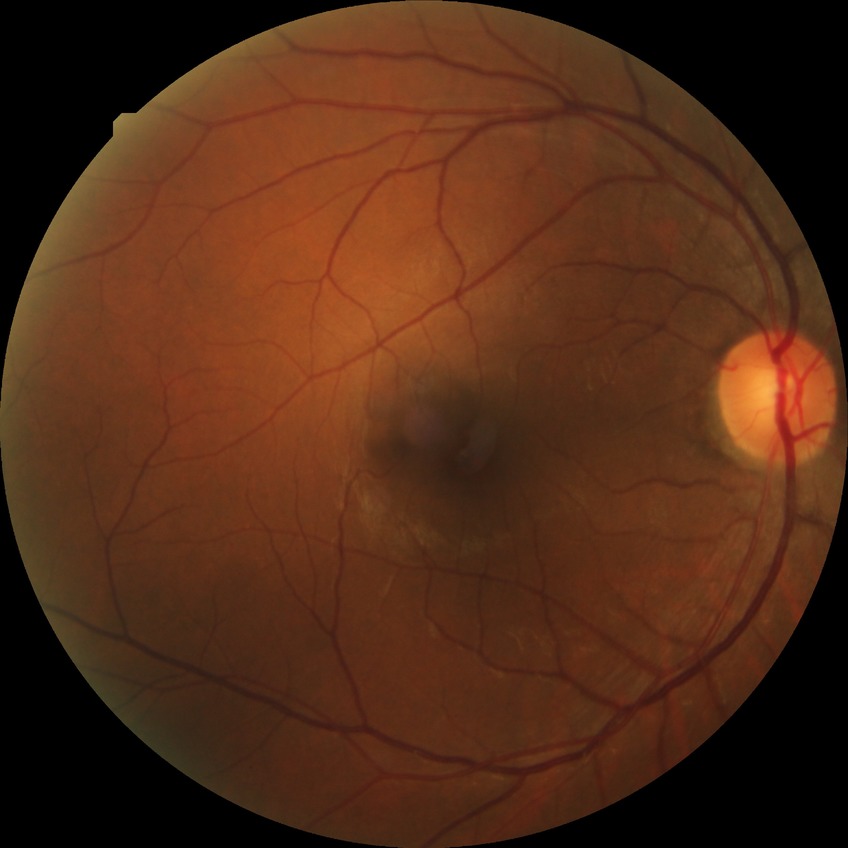 - modified Davis classification — no diabetic retinopathy